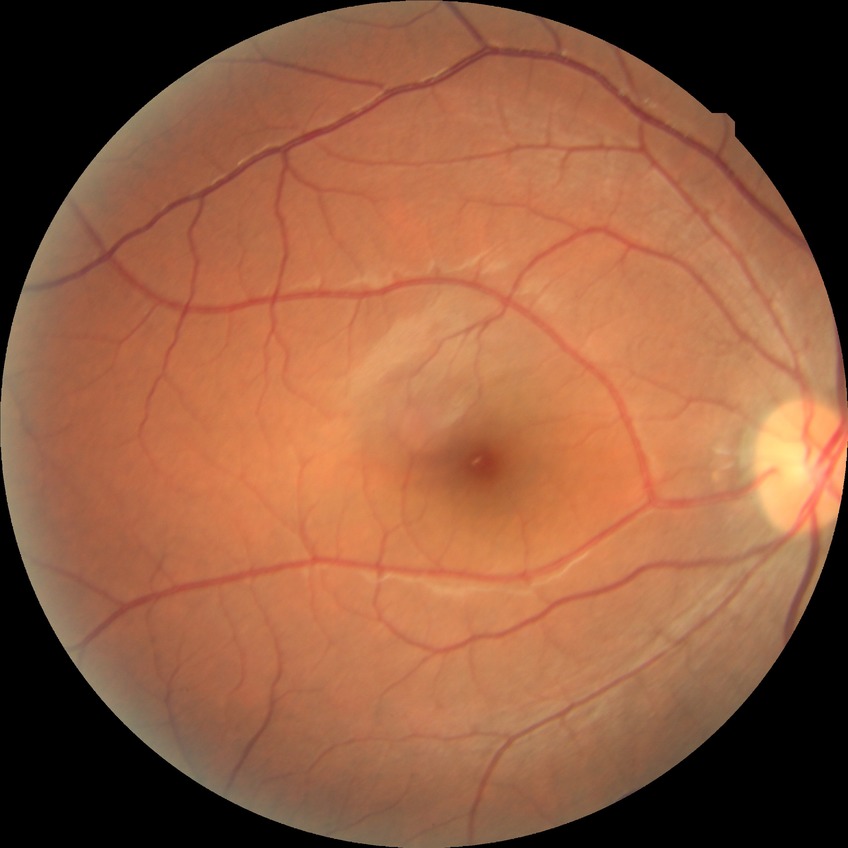

Diabetic retinopathy (DR) is no diabetic retinopathy (NDR).